2352x1568px: 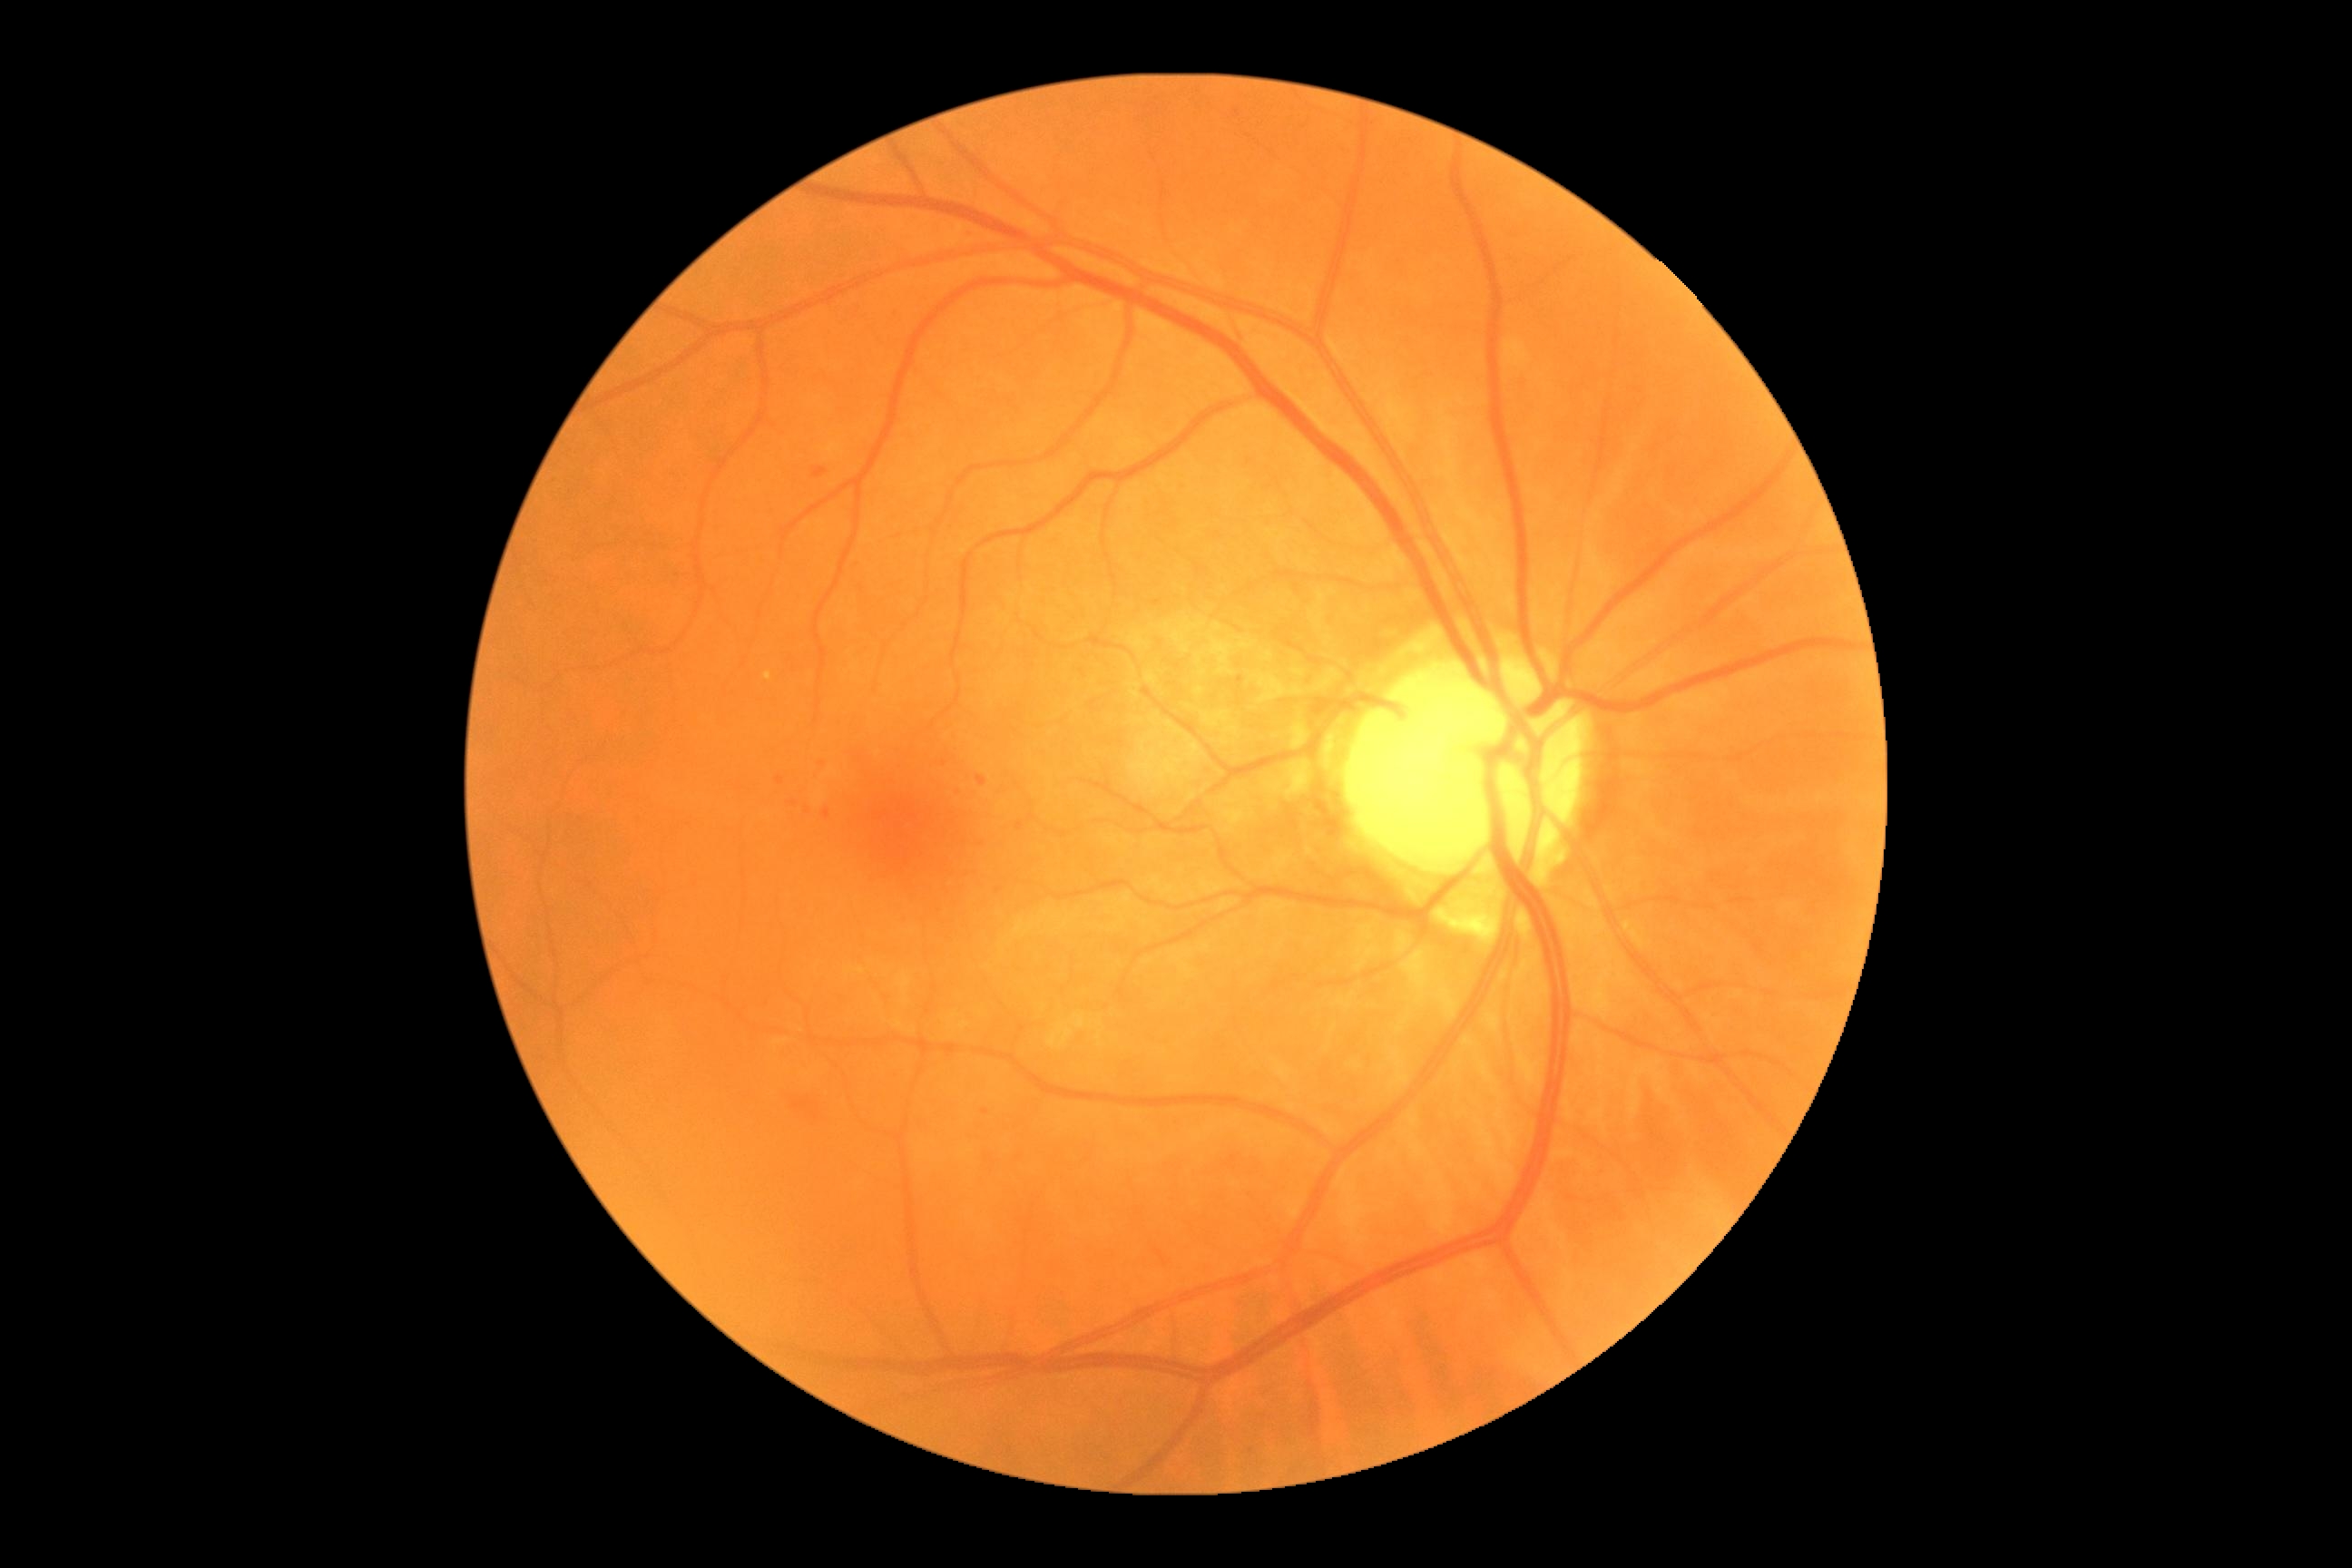

DR: grade 2.